Retinal fundus photograph.
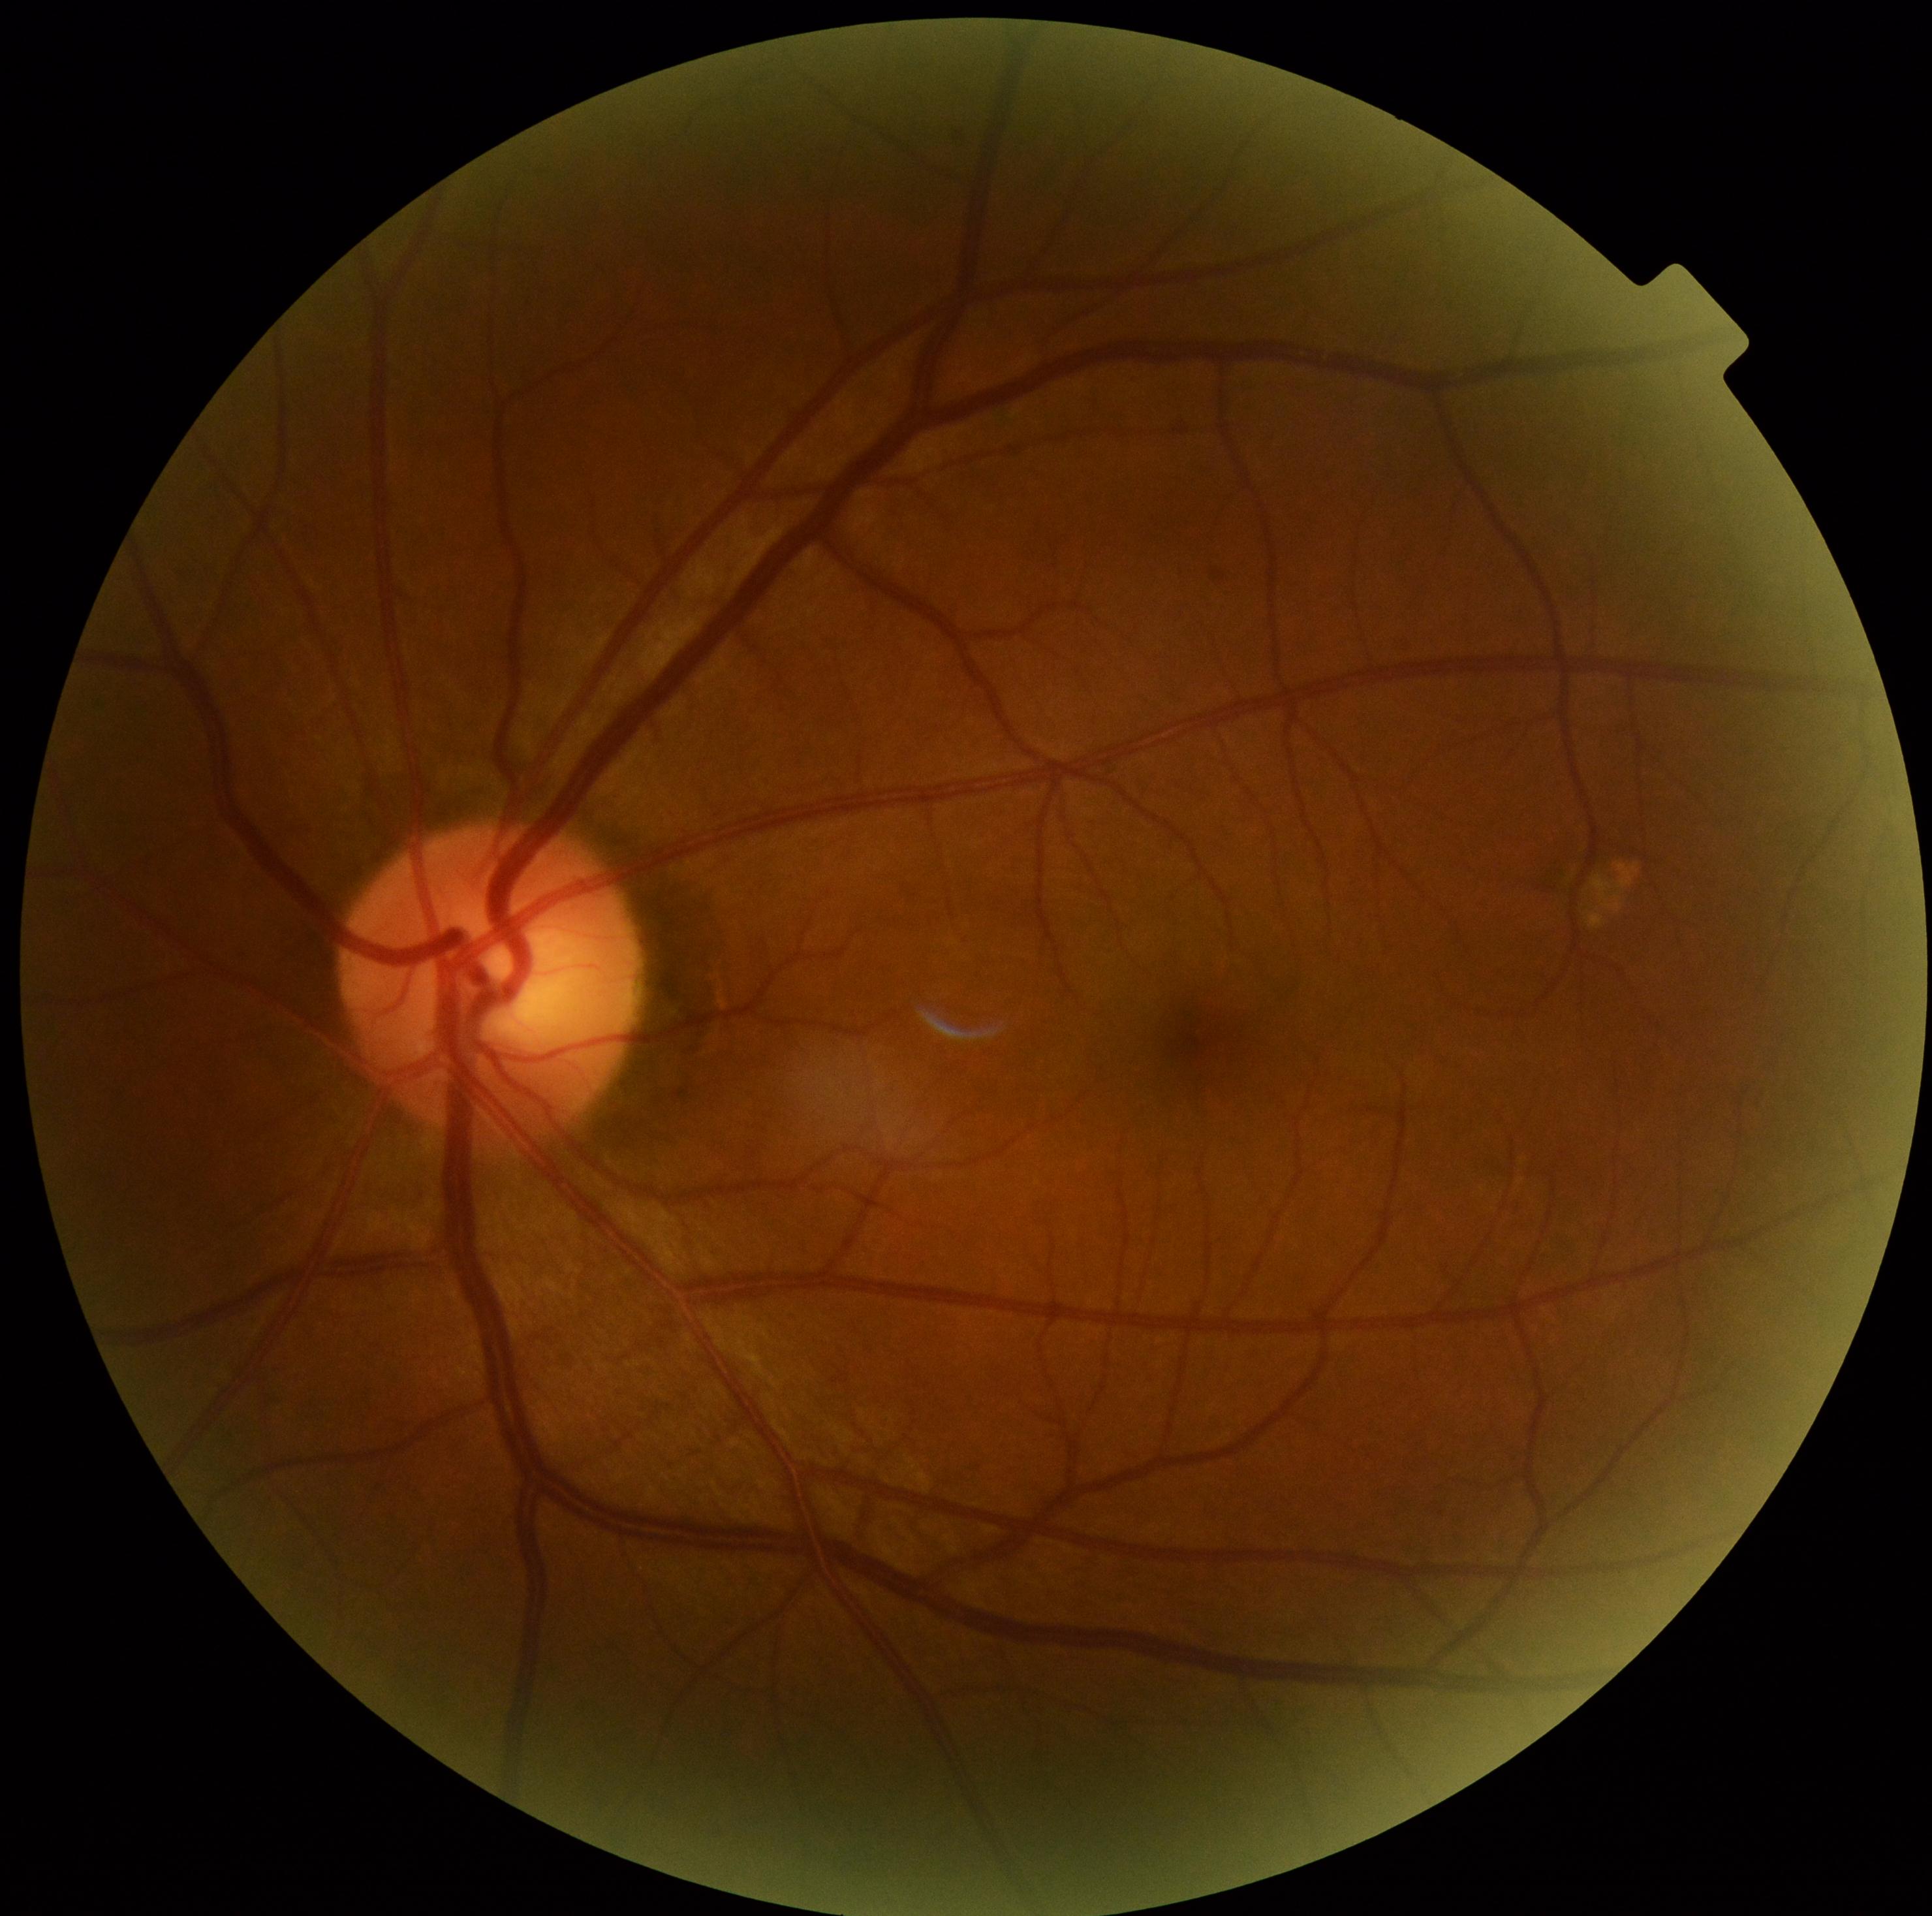

diabetic retinopathy (DR): no apparent diabetic retinopathy (grade 0), DR impression: no DR findings.